Wide-field fundus image from infant ROP screening: 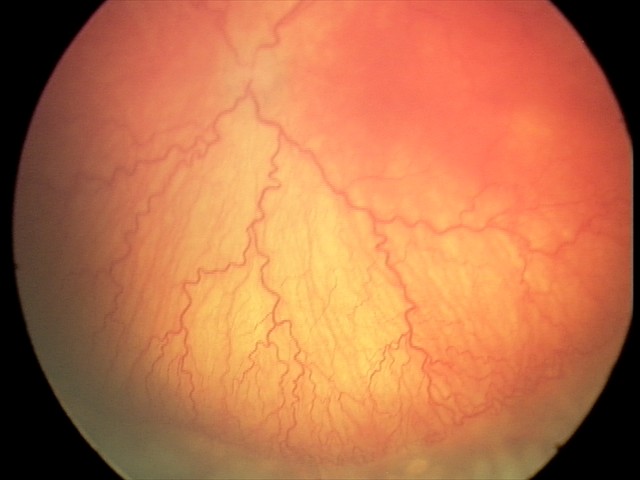 Plus disease present. Screening series with aggressive retinopathy of prematurity — rapidly progressive severe ROP with prominent plus disease, often without classic stage progression.